Posterior pole photograph. FOV: 45 degrees. 848 by 848 pixels. NIDEK AFC-230 fundus camera. Diabetic retinopathy graded by the modified Davis classification. No pharmacologic dilation.
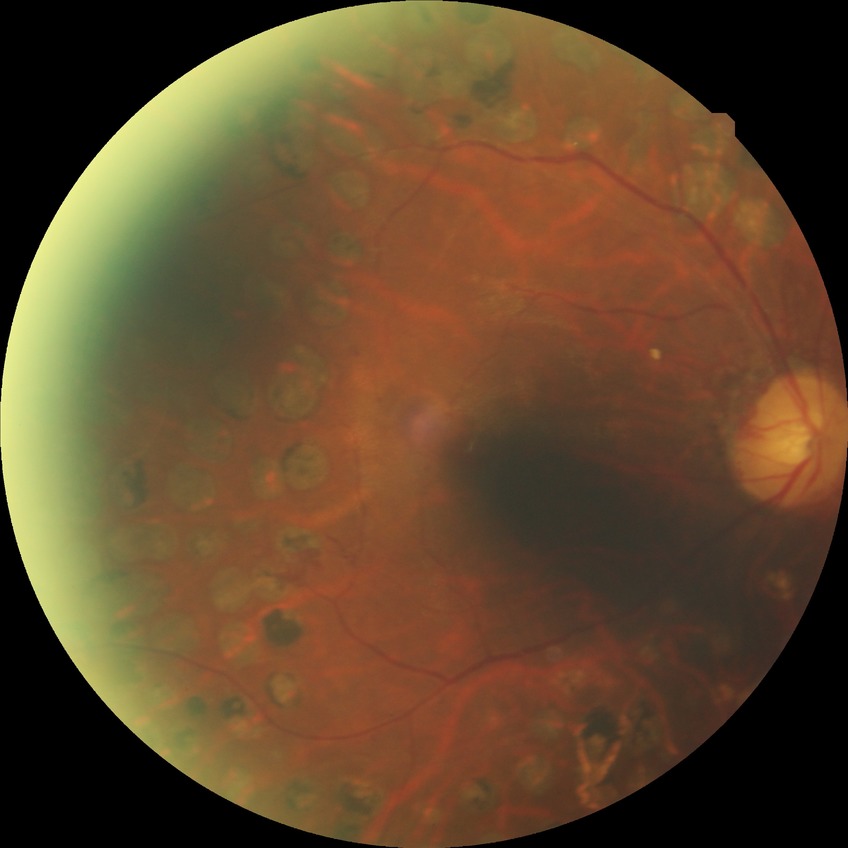
davis_grade: proliferative diabetic retinopathy (PDR)